Image size 2352x1568
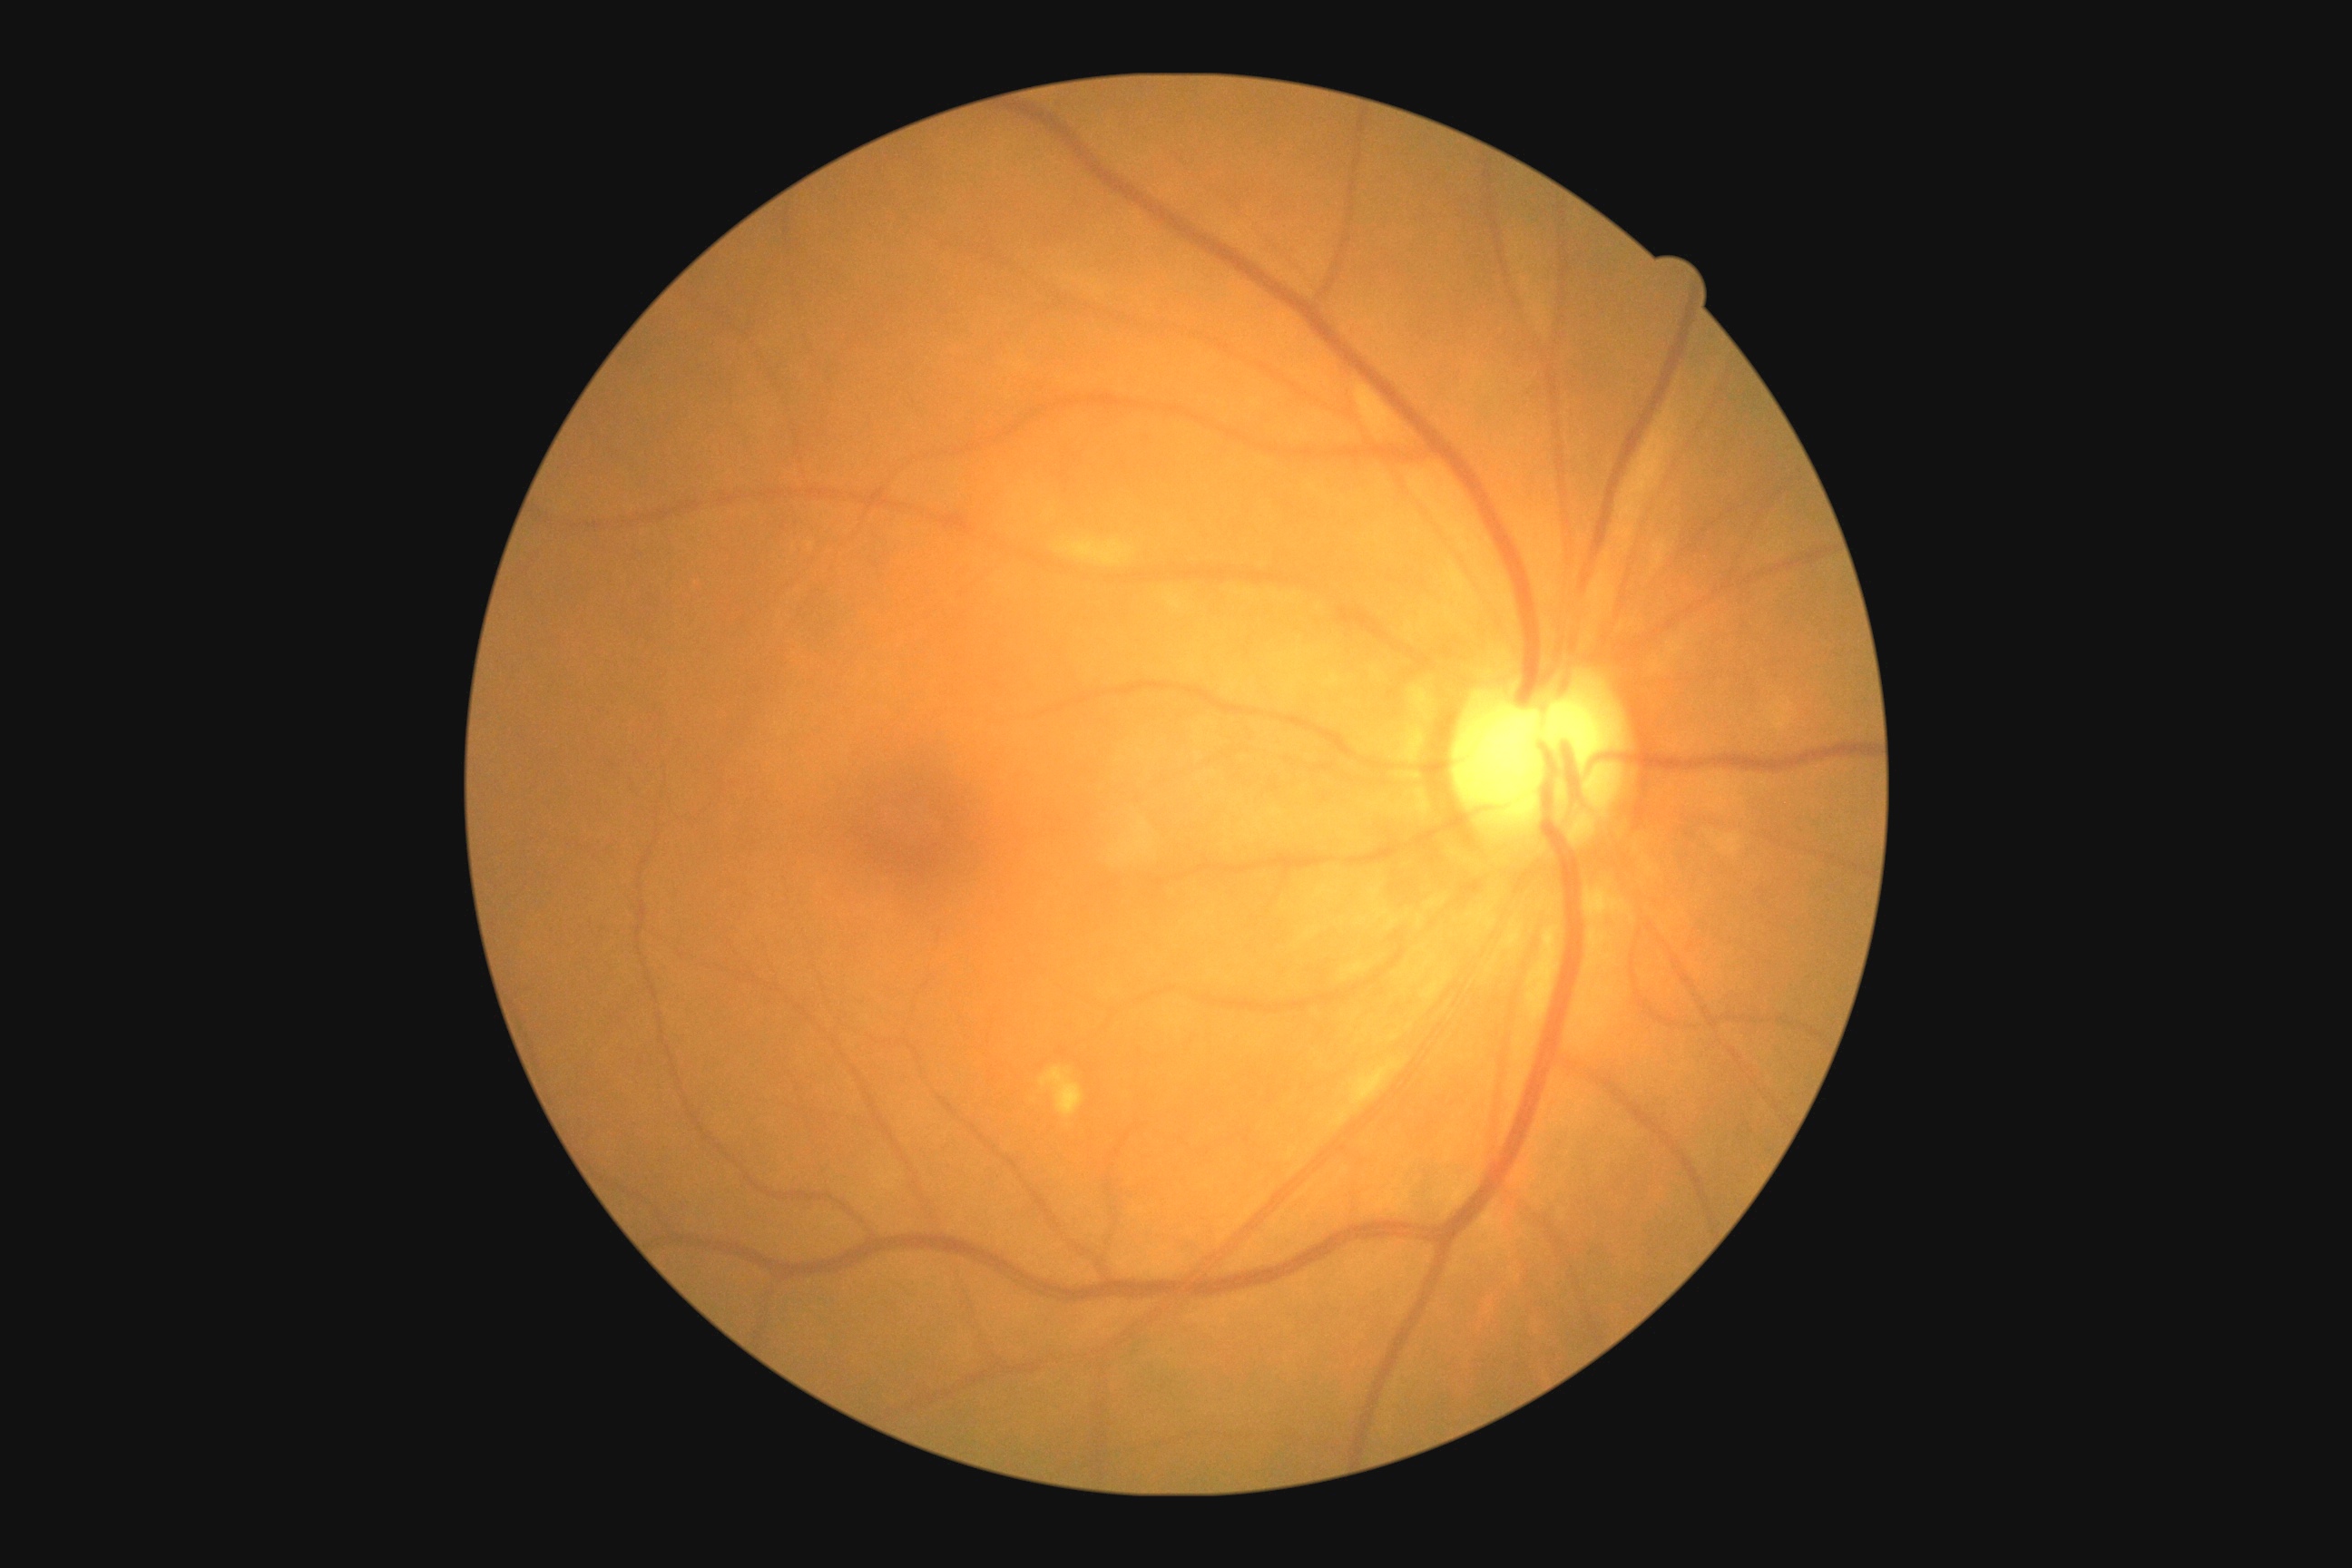

{"dr_category": "non-proliferative diabetic retinopathy", "dr_grade": "moderate non-proliferative diabetic retinopathy (grade 2)"}